2352x1568. 45-degree field of view — 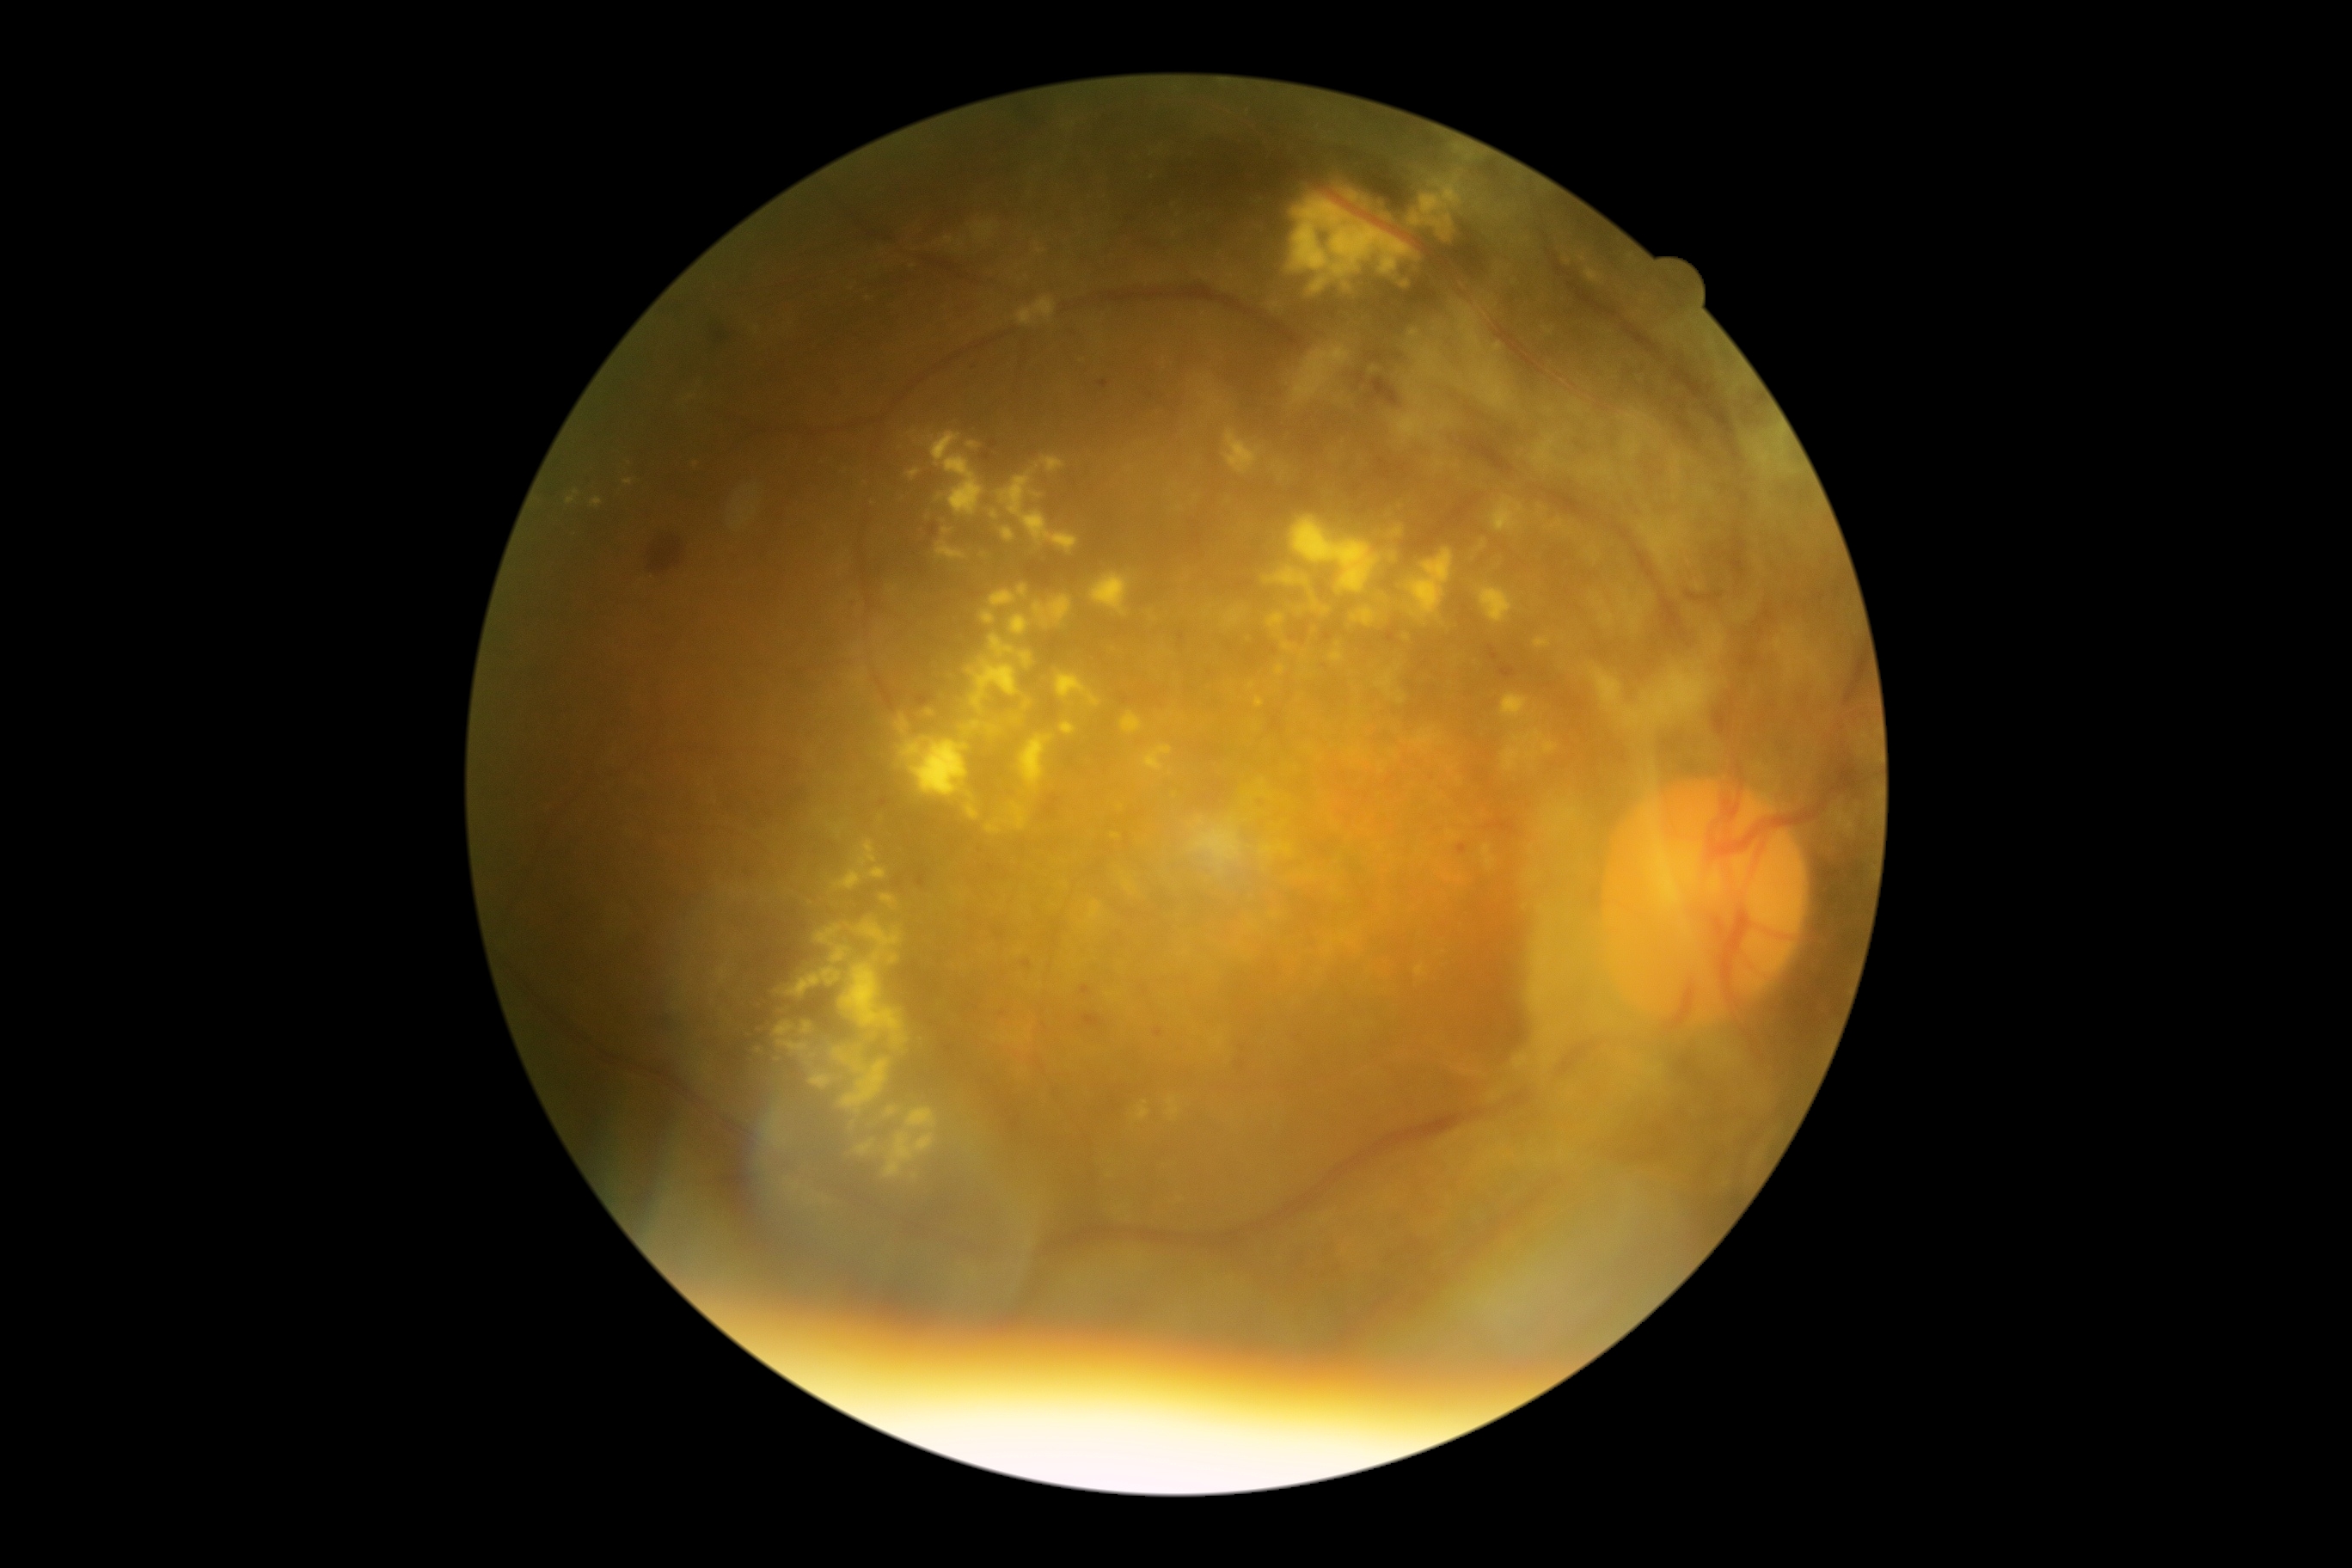

diabetic retinopathy = 4.